Wide-field fundus image from infant ROP screening: 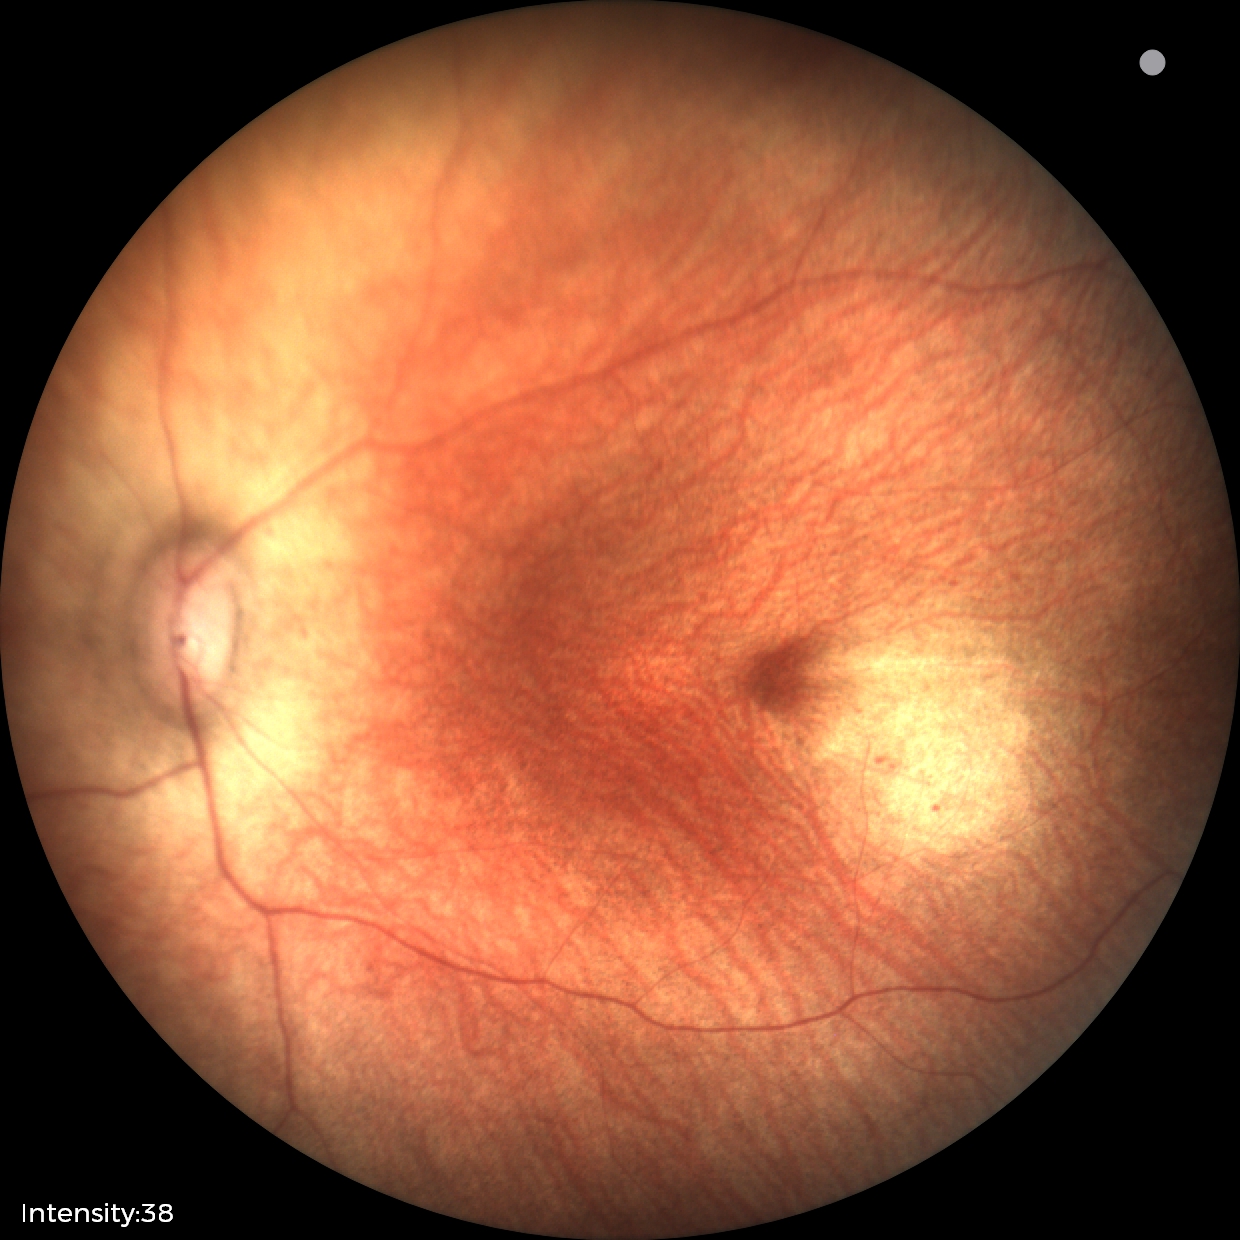 Assessment: physiological appearance with no retinal pathology.